Retinal fundus photograph, without pupil dilation.
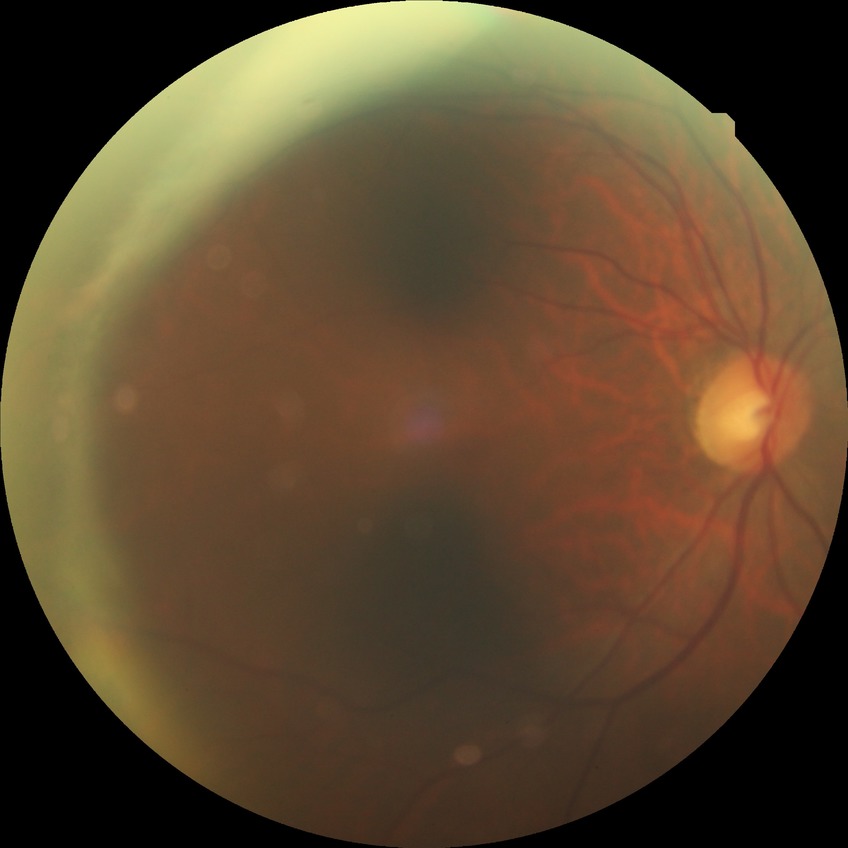

Retinopathy stage is no diabetic retinopathy.